Phoenix ICON, 100° FOV · wide-field fundus photograph from neonatal ROP screening — 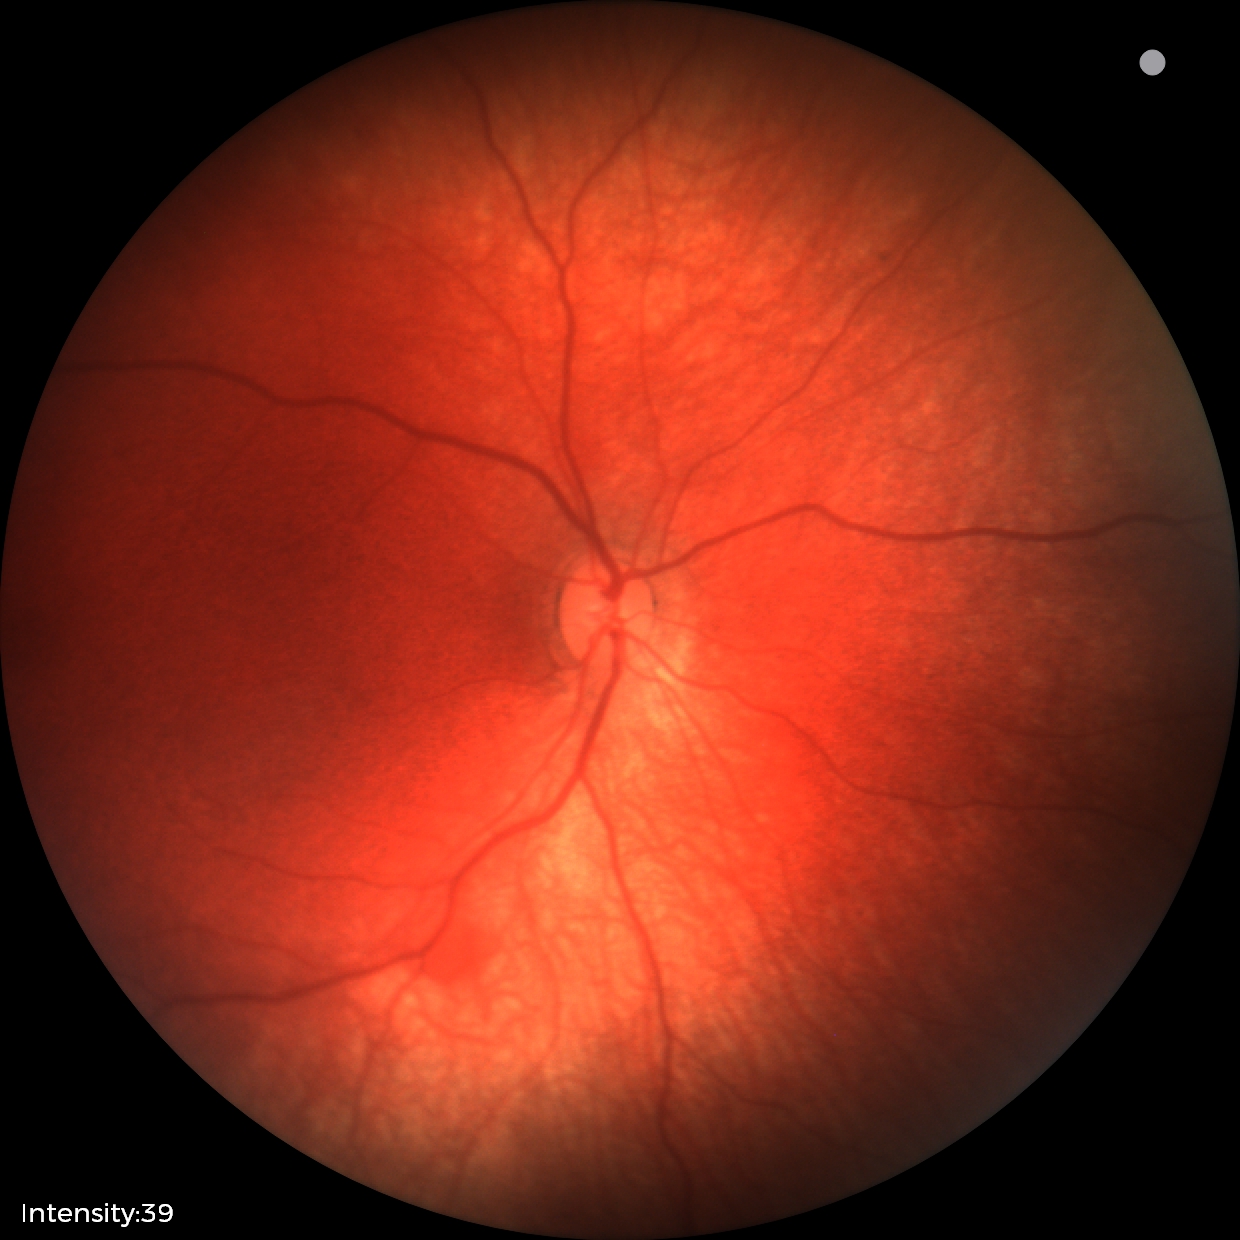
Assessment = retinal hemorrhages.